Color fundus photograph, 45° field of view, without pupil dilation.
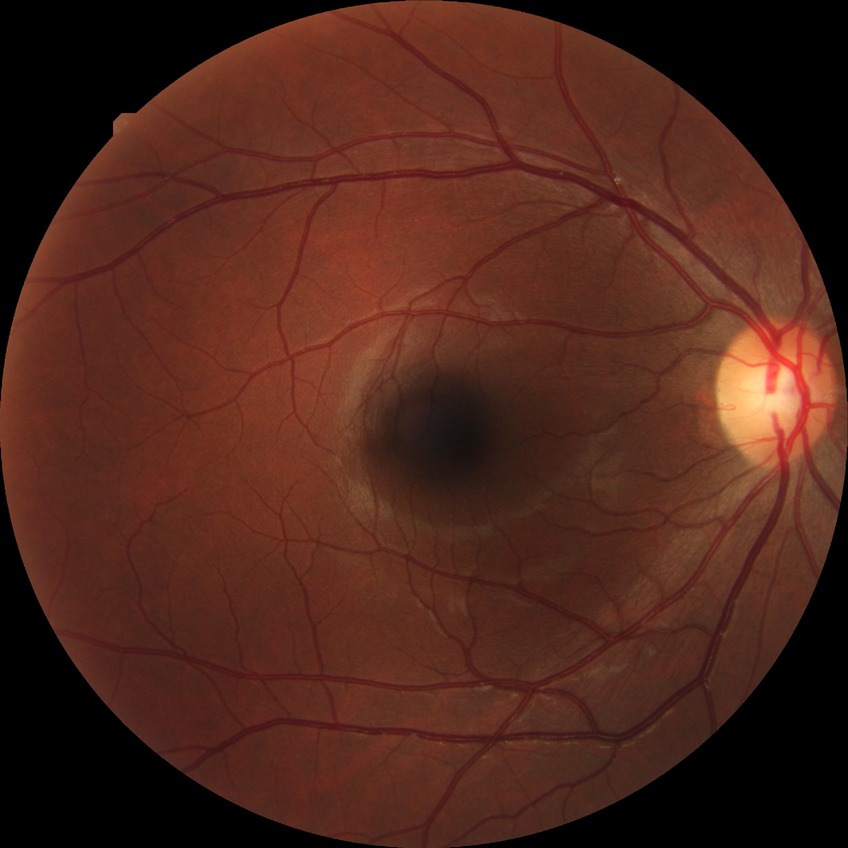
Diabetic retinopathy severity: no diabetic retinopathy.